Retinal fundus photograph. NIDEK AFC-230. 848 by 848 pixels. Modified Davis classification: 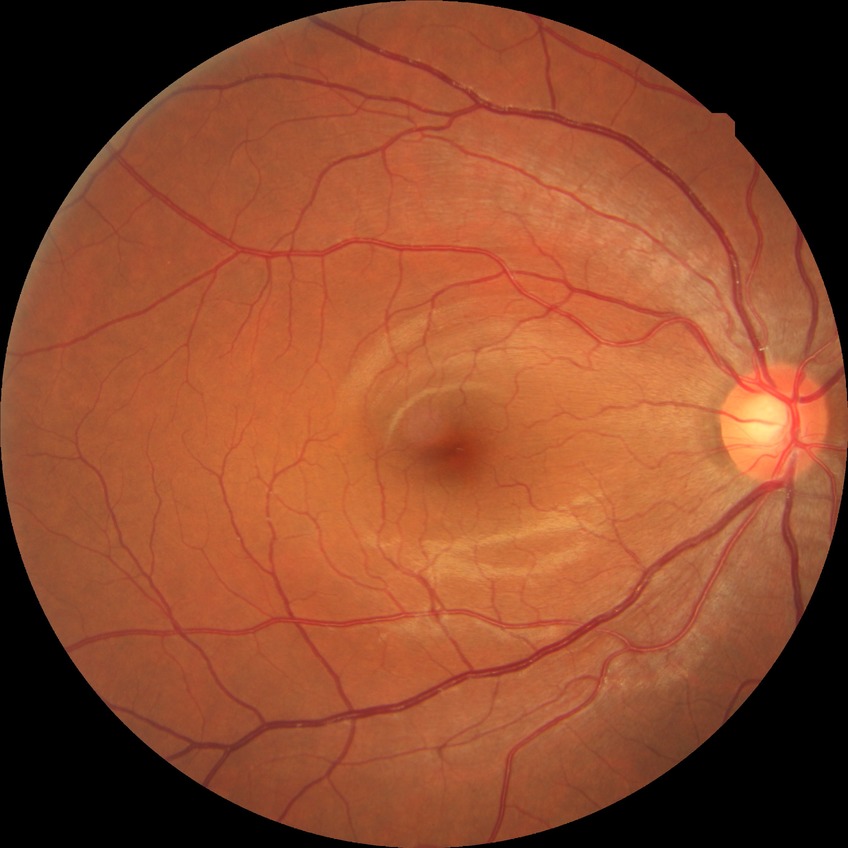

DR: NDR. No diabetic retinal disease findings.